Camera: NIDEK AFC-230. 848x848px. Nonmydriatic fundus photograph: 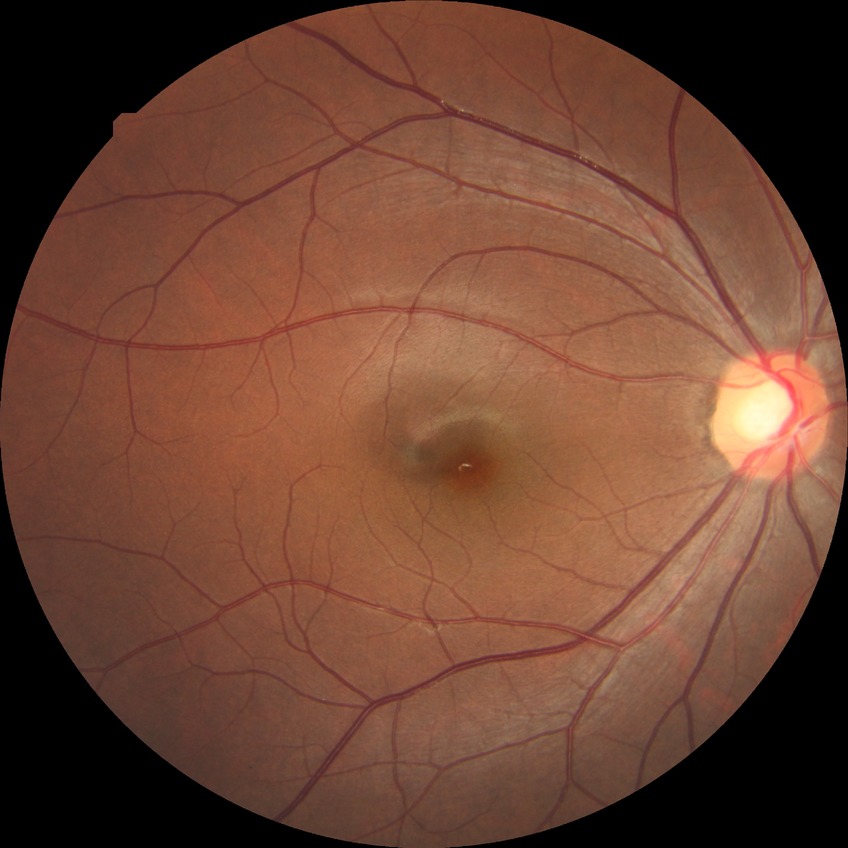
DR: NDR.